45-degree field of view; nonmydriatic fundus photograph; acquired with a NIDEK AFC-230; 848 by 848 pixels; color fundus photograph
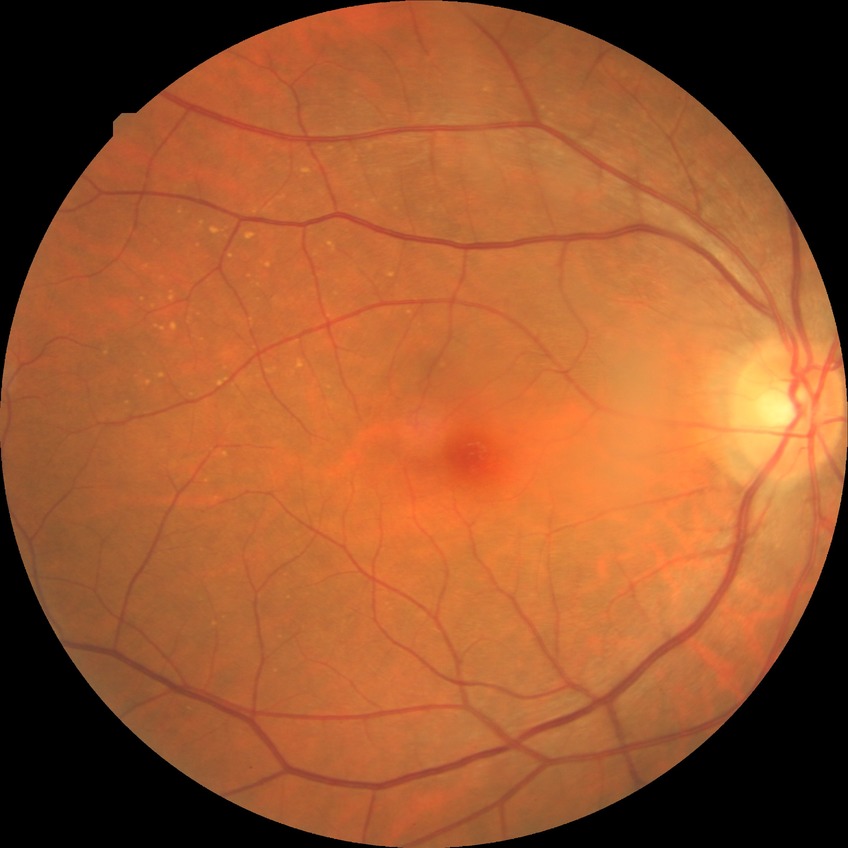

Retinopathy grade: no diabetic retinopathy.